Wide-field fundus image from infant ROP screening: 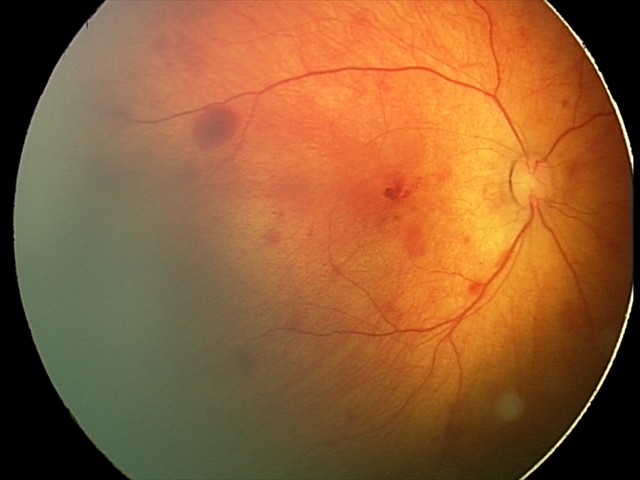 Screening: retinal hemorrhages.